Fundus photo · 2048 by 1536 pixels — 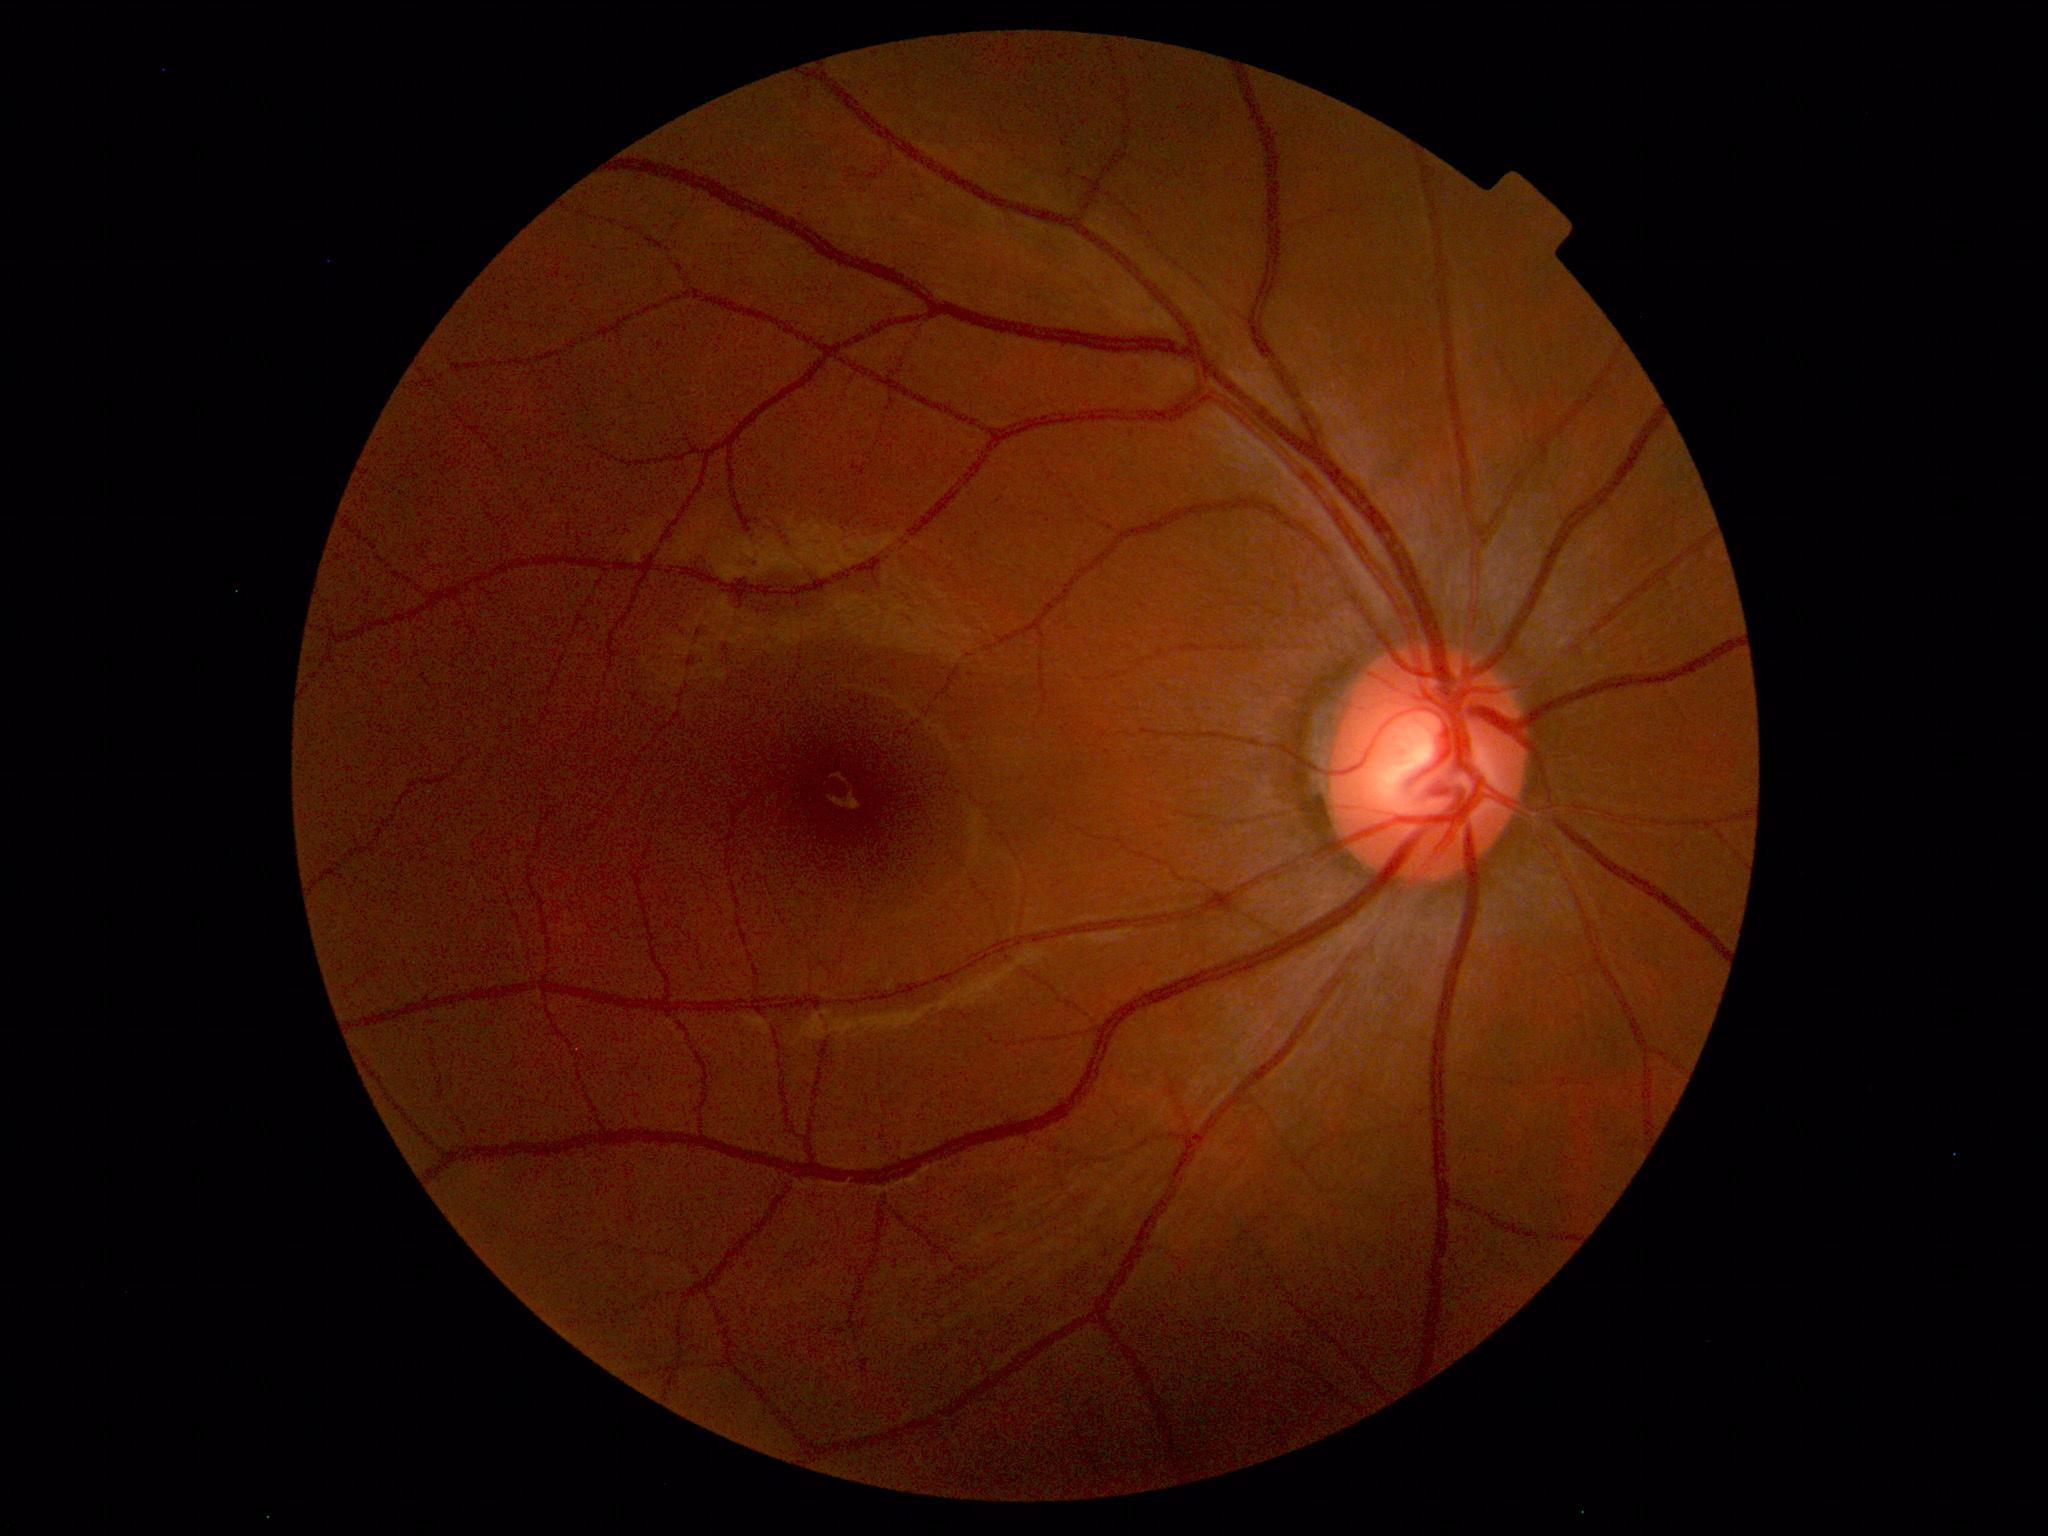

The fundus appears normal with no pathological findings.